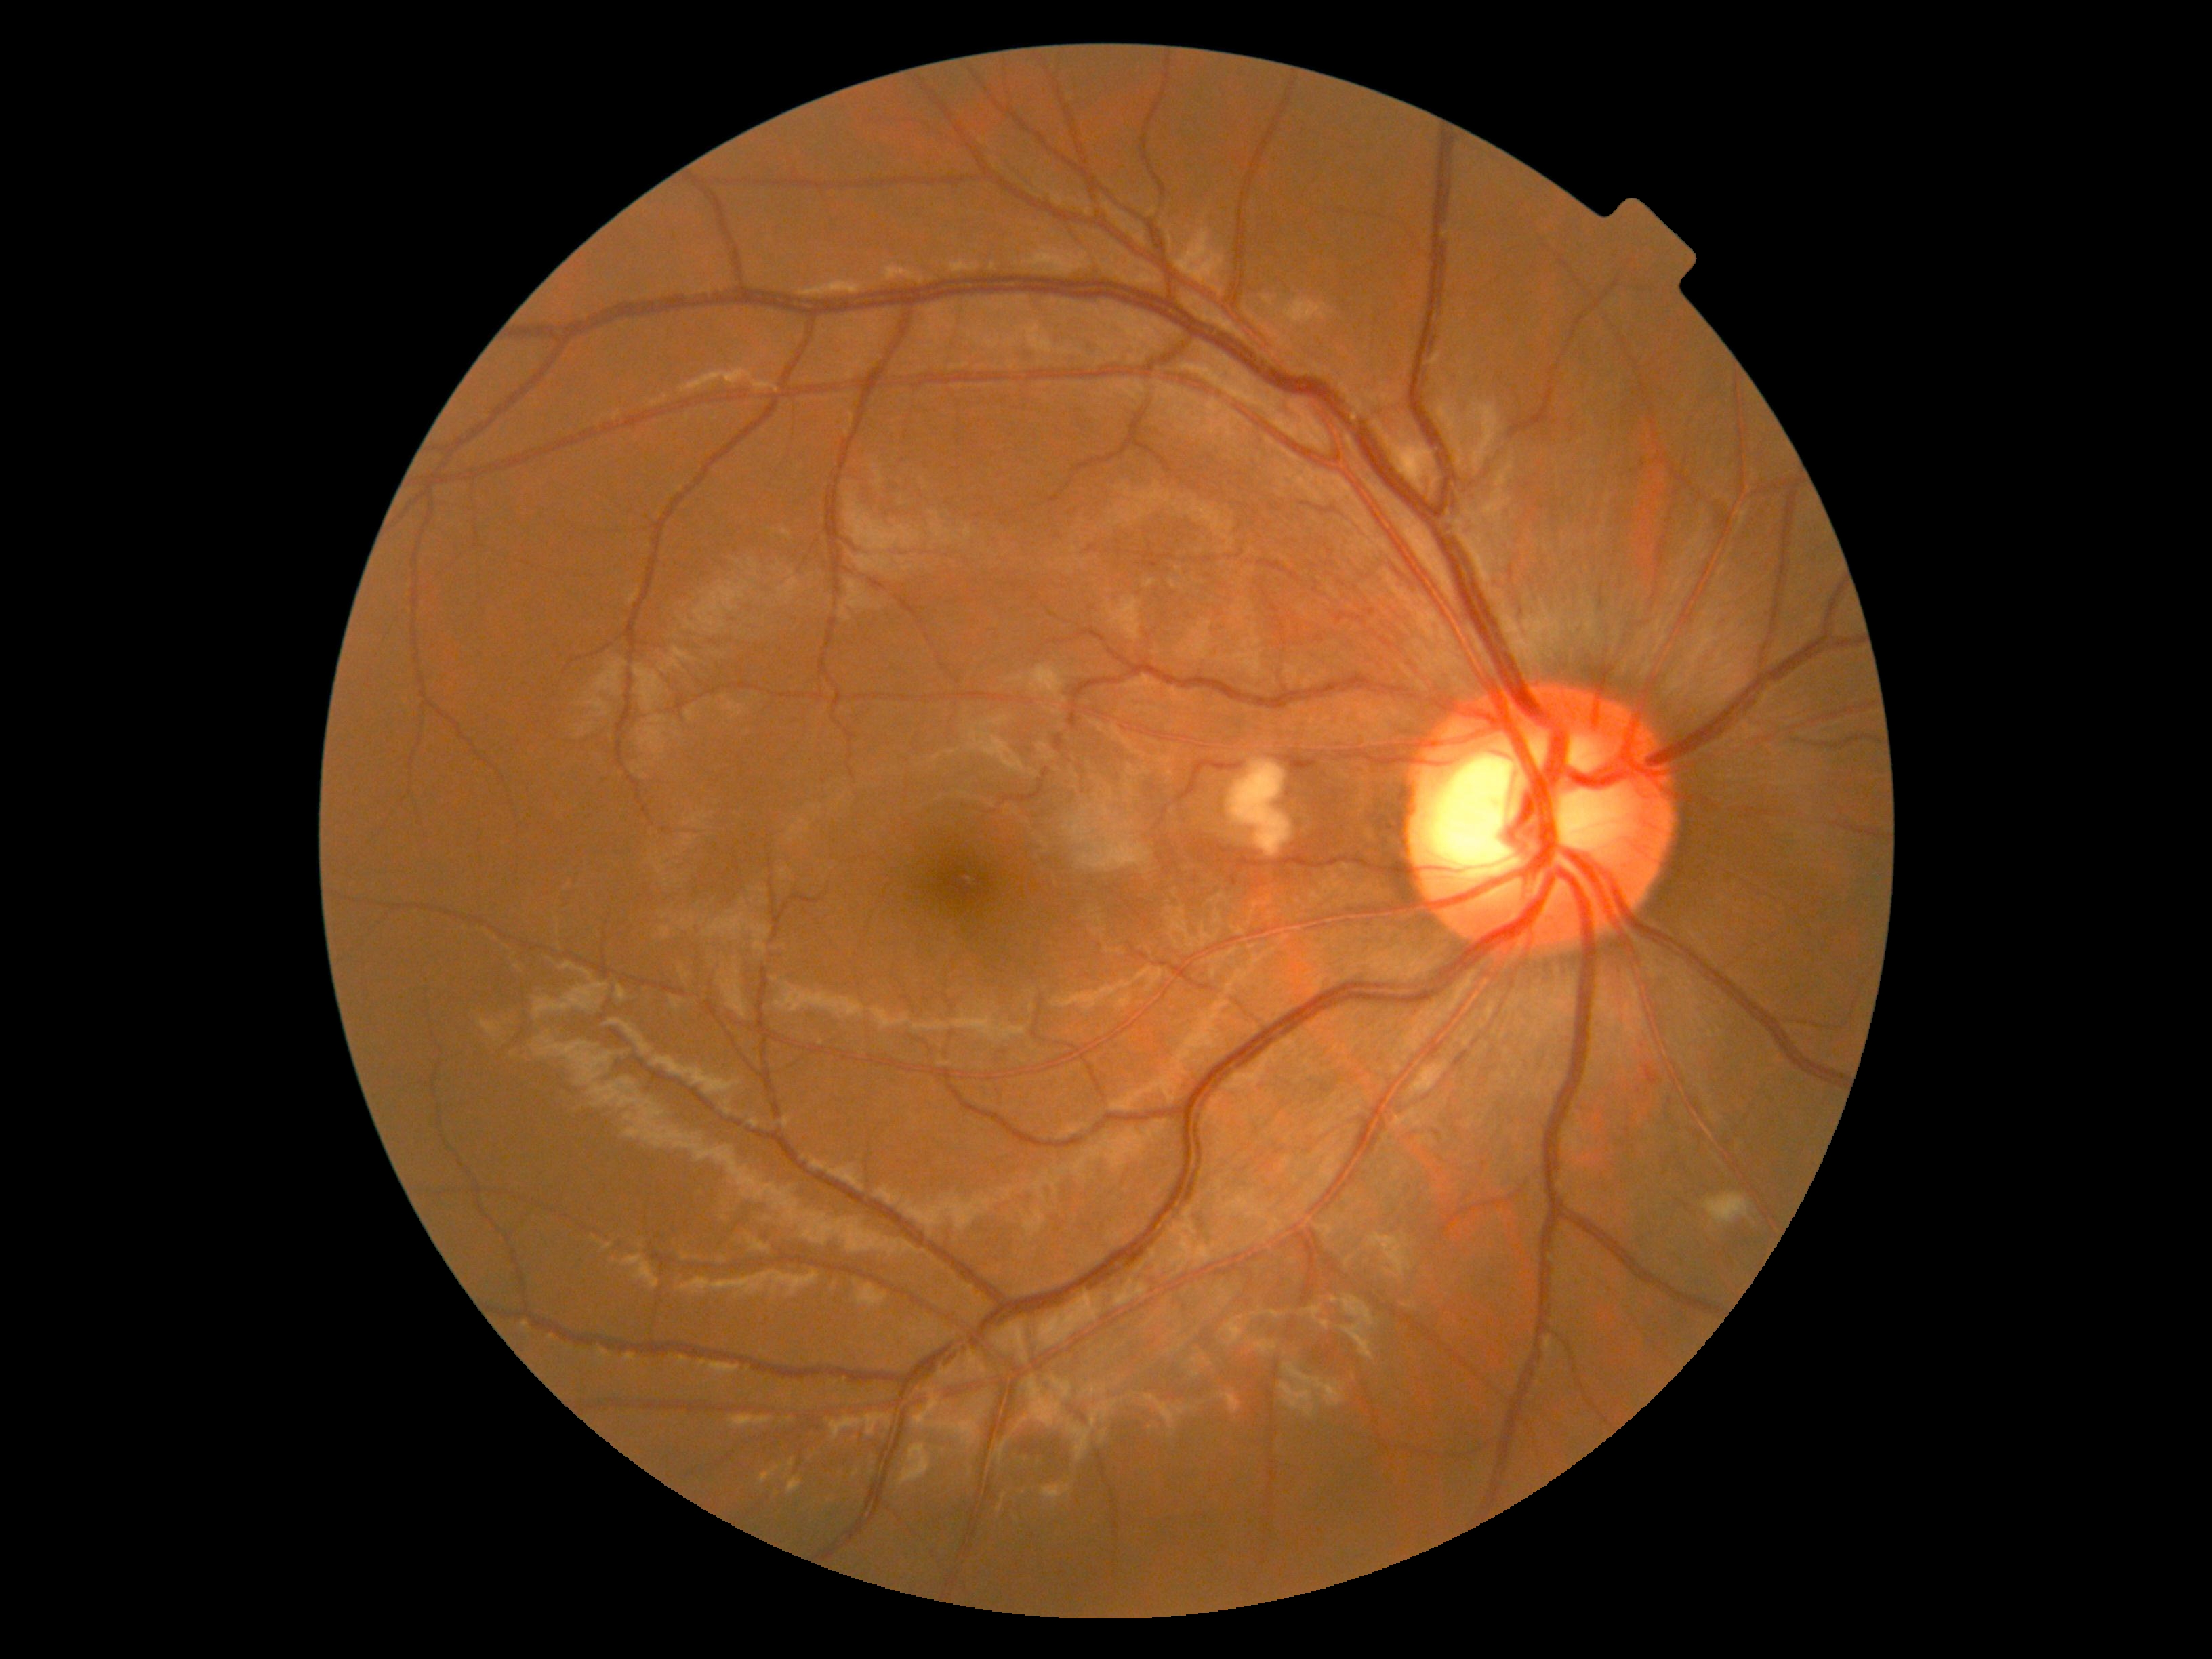

Diabetic retinopathy grade: moderate non-proliferative diabetic retinopathy (2)
microaneurysms: none
hard exudates: none
soft exudates: 1703, 1192, 1750, 1225; 1229, 760, 1292, 857
hemorrhages: 1645, 1065, 1660, 1086; 1150, 559, 1162, 567